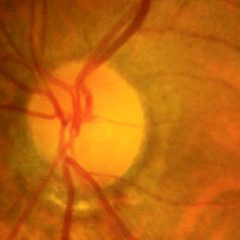

Demonstrates no evidence of glaucoma.